50° field of view, captured after pupil dilation, 1932x1932px: 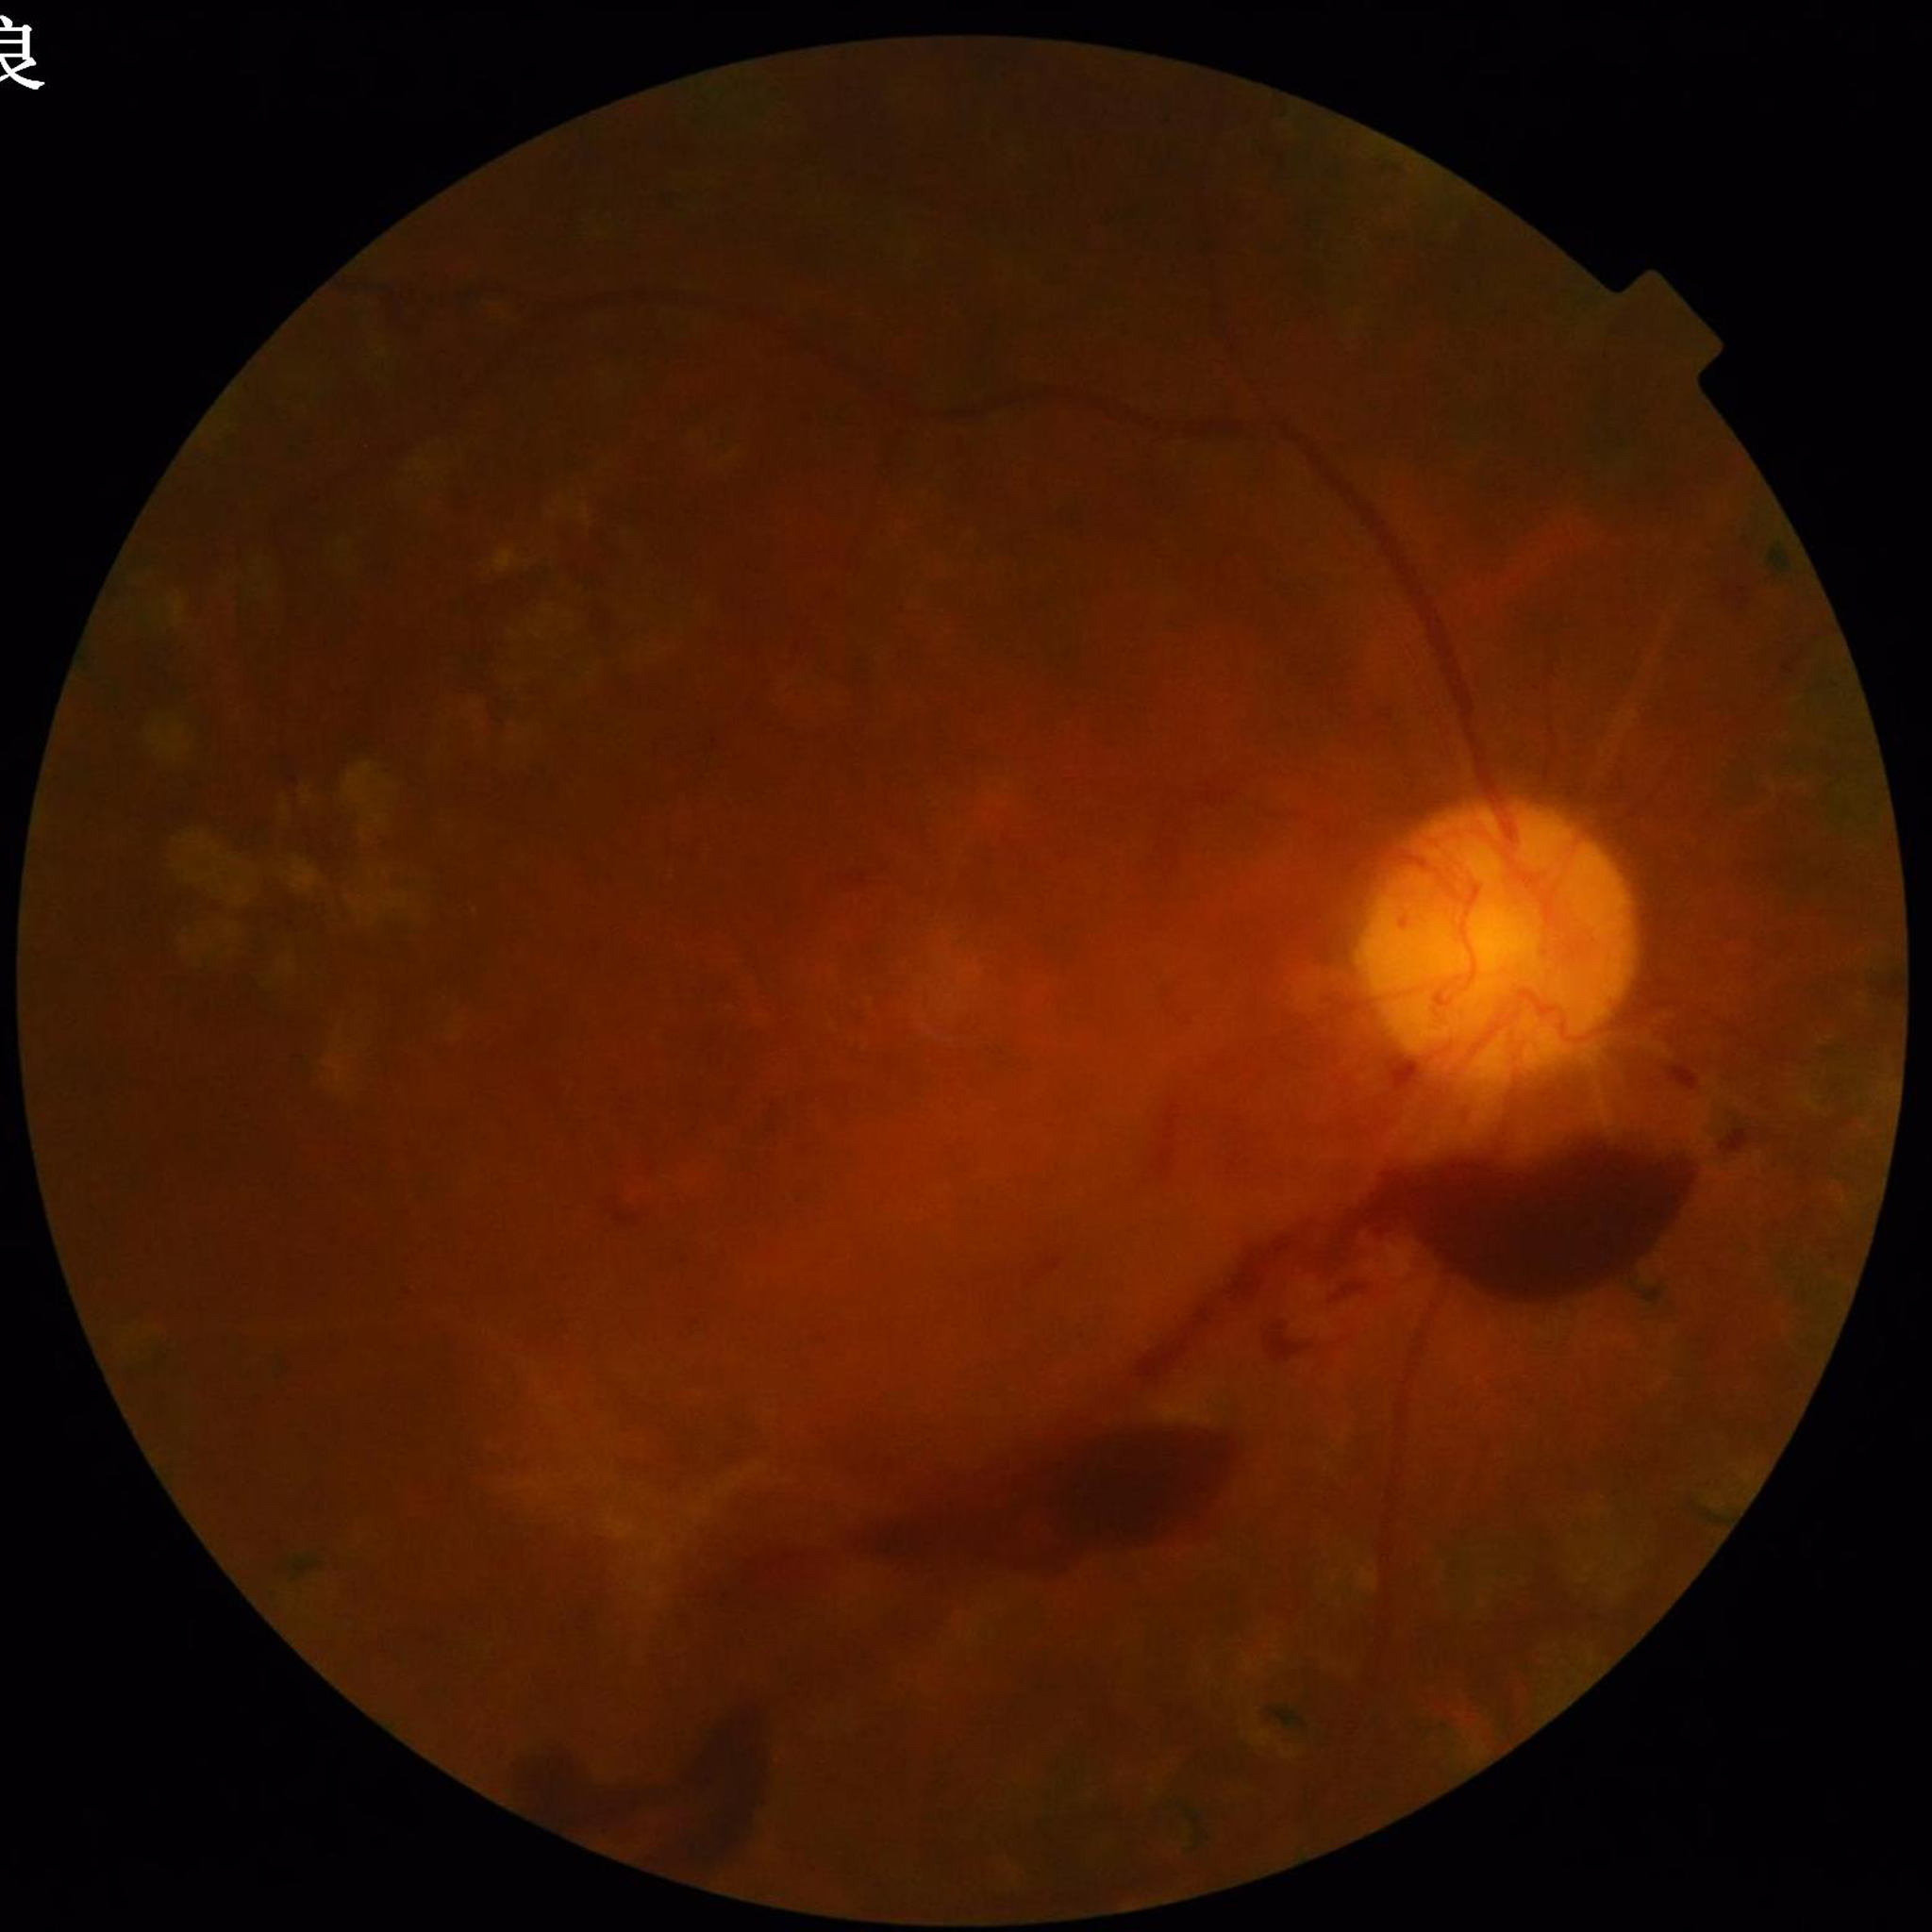 Diagnosed with diabetic retinopathy. Automated quality assessment: blur present, illumination/color distortion present, contrast adequate.